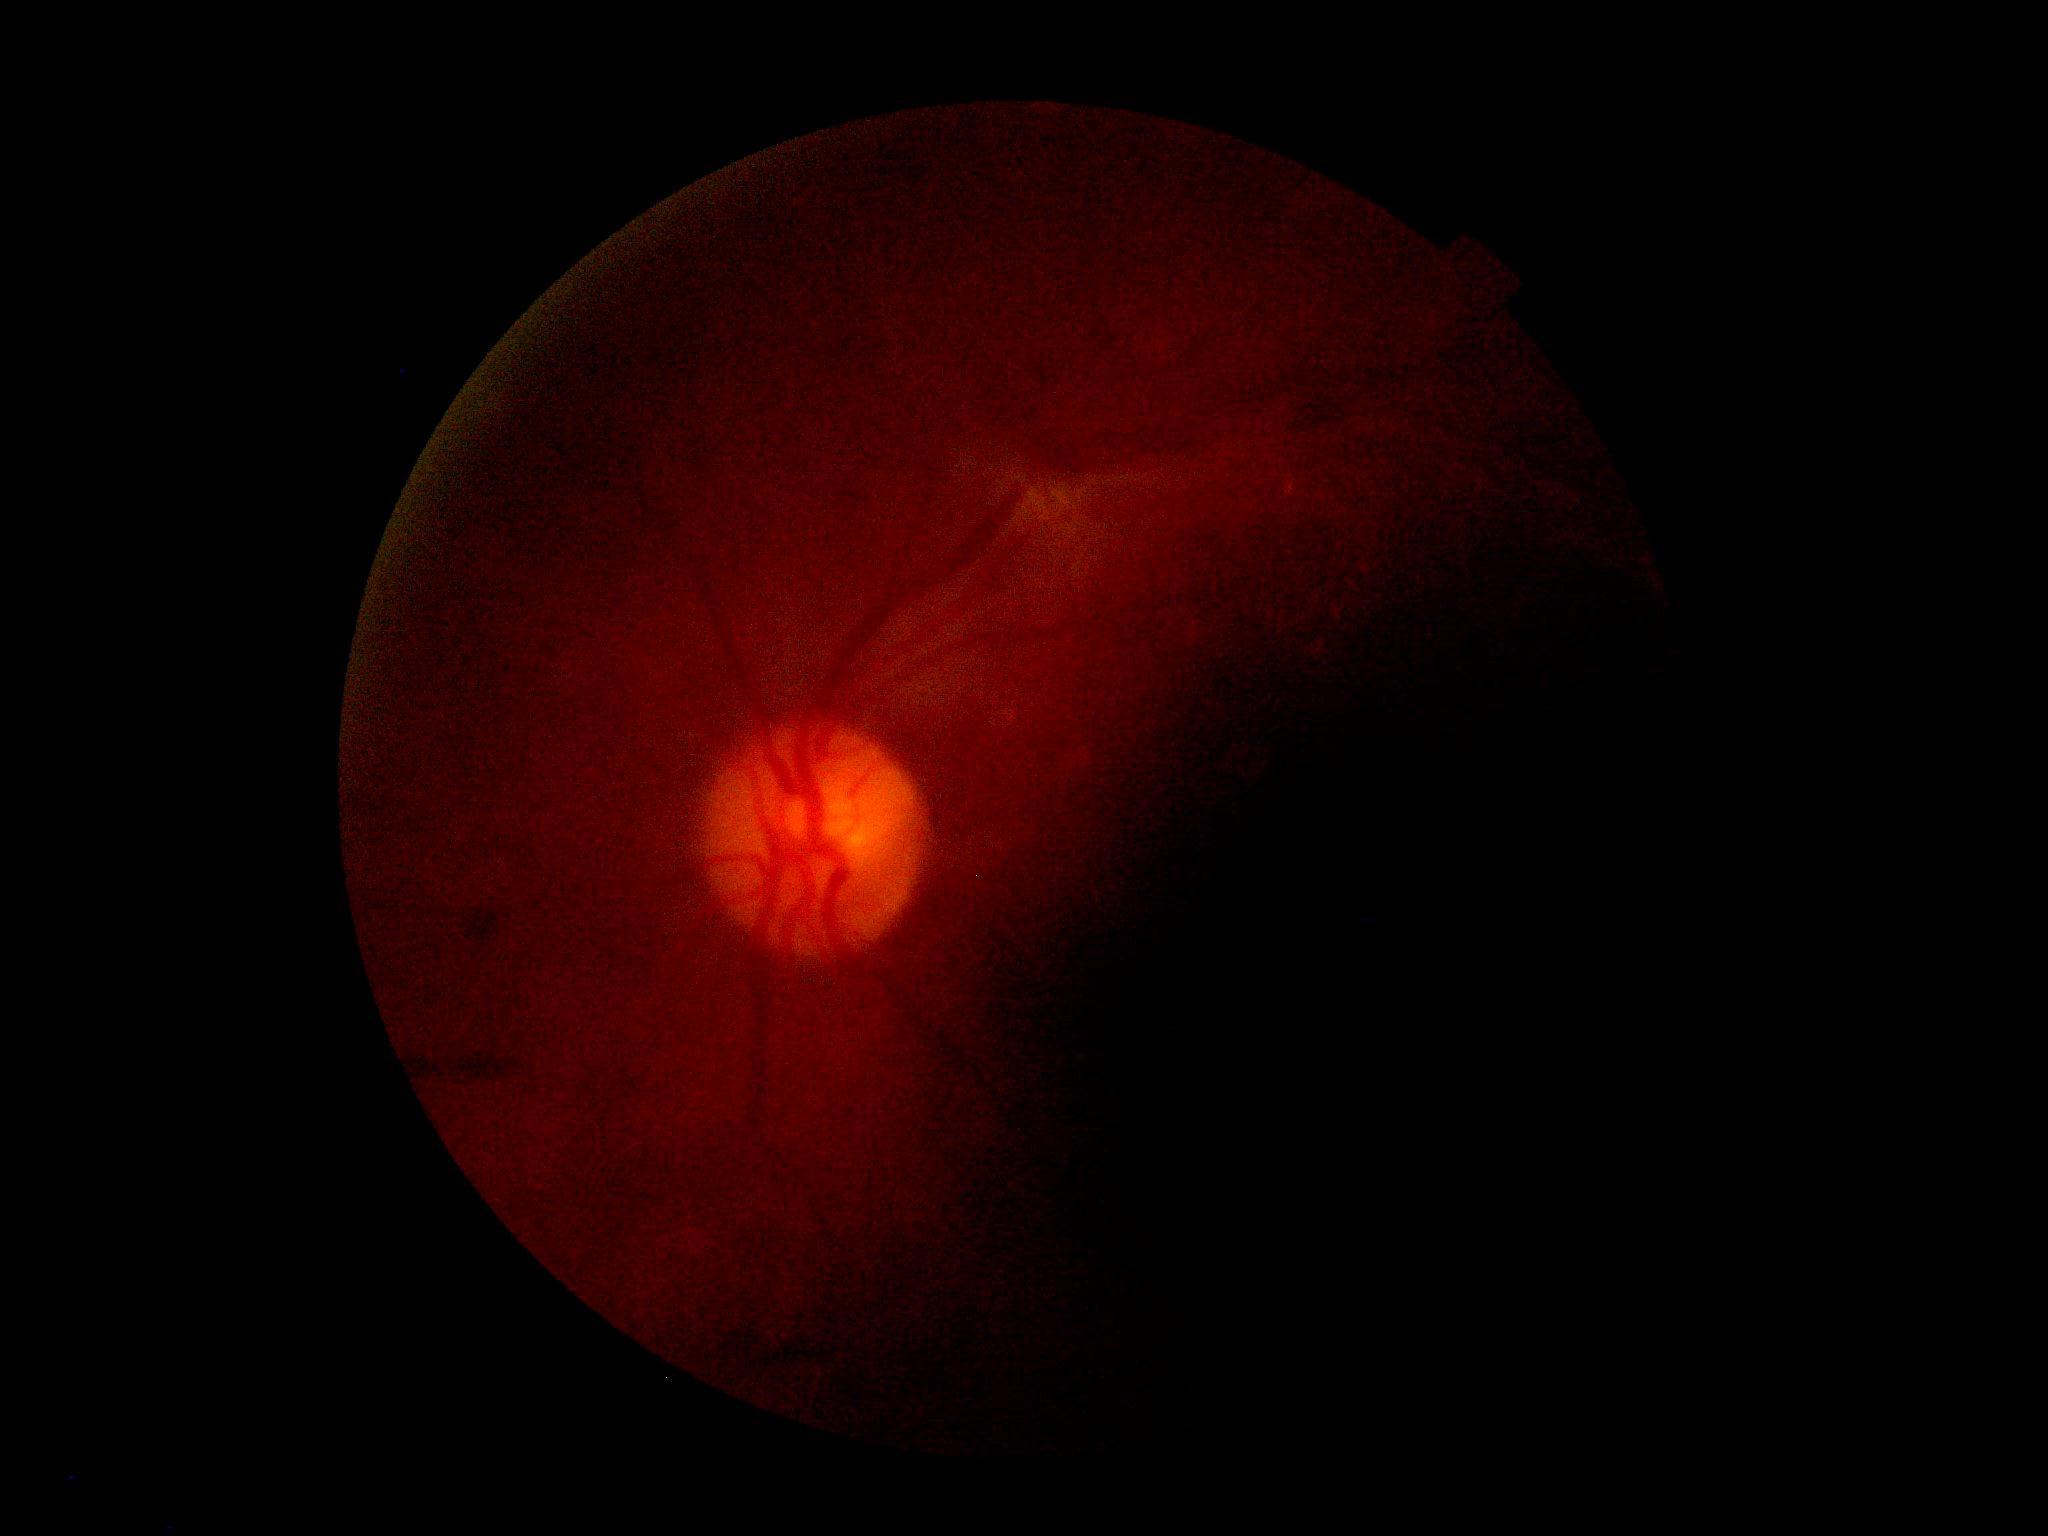 Diabetic retinopathy severity: grade 2 (moderate NPDR).